Retinal fundus photograph · 240 by 240 pixels:
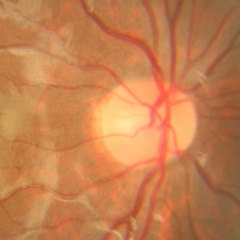
There is evidence of no glaucomatous optic neuropathy.